2048 by 1536 pixels; 45-degree field of view.
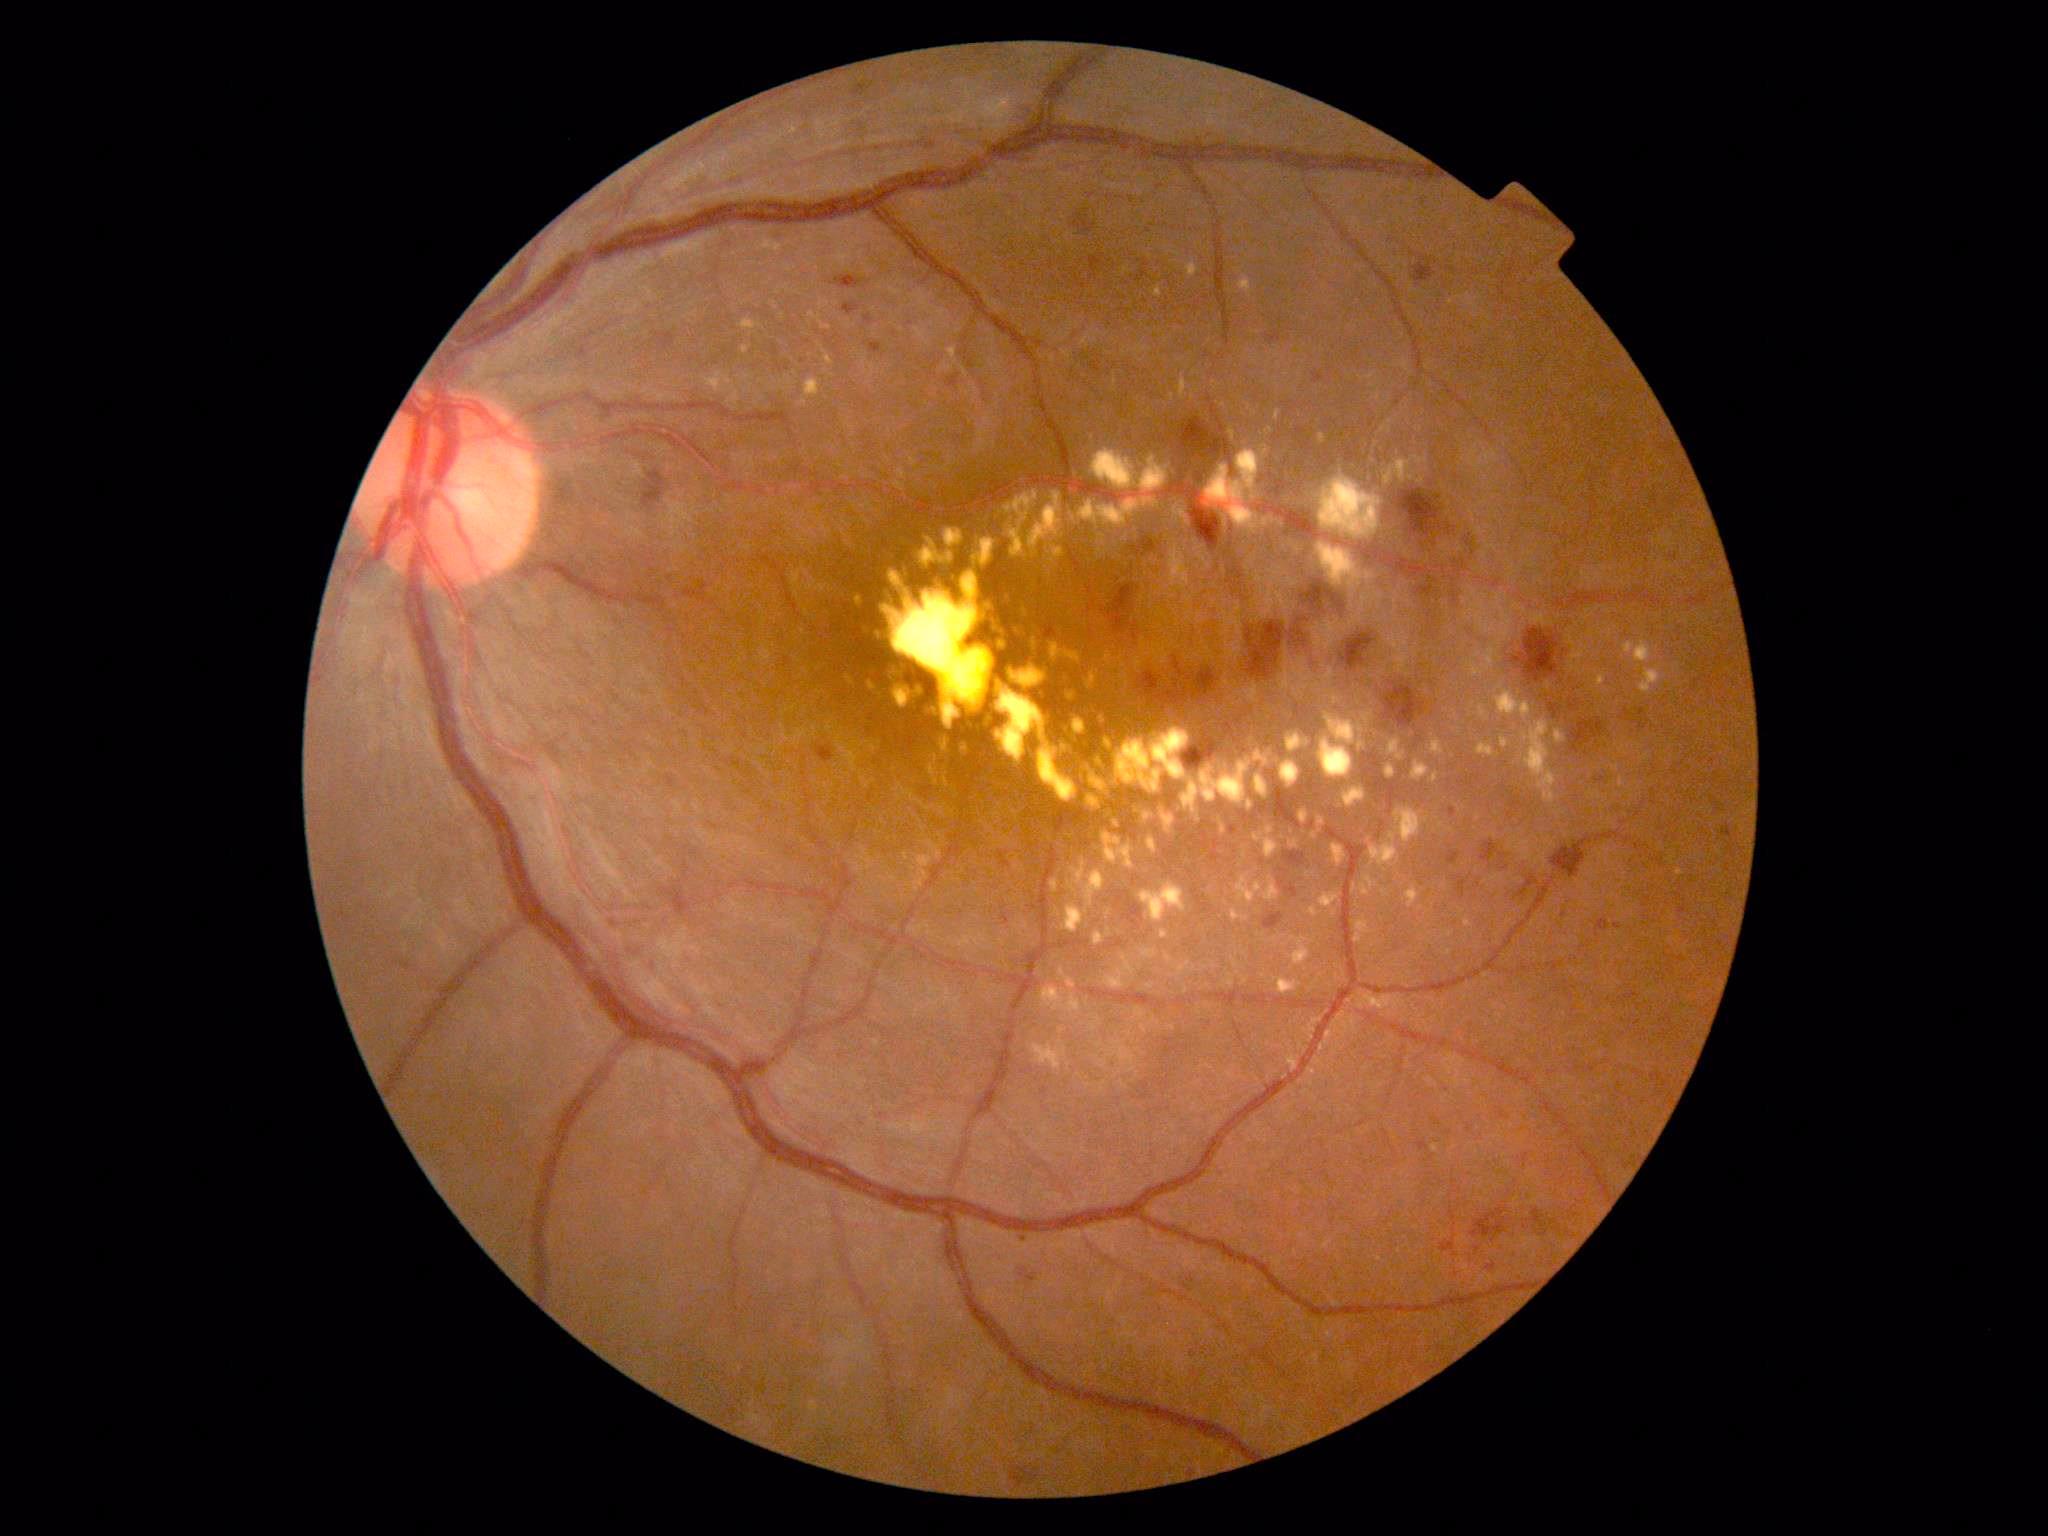

Diabetic retinopathy (DR): 2/4 — more than just microaneurysms but less than severe NPDR.
The retinopathy is classified as non-proliferative diabetic retinopathy.